45° field of view
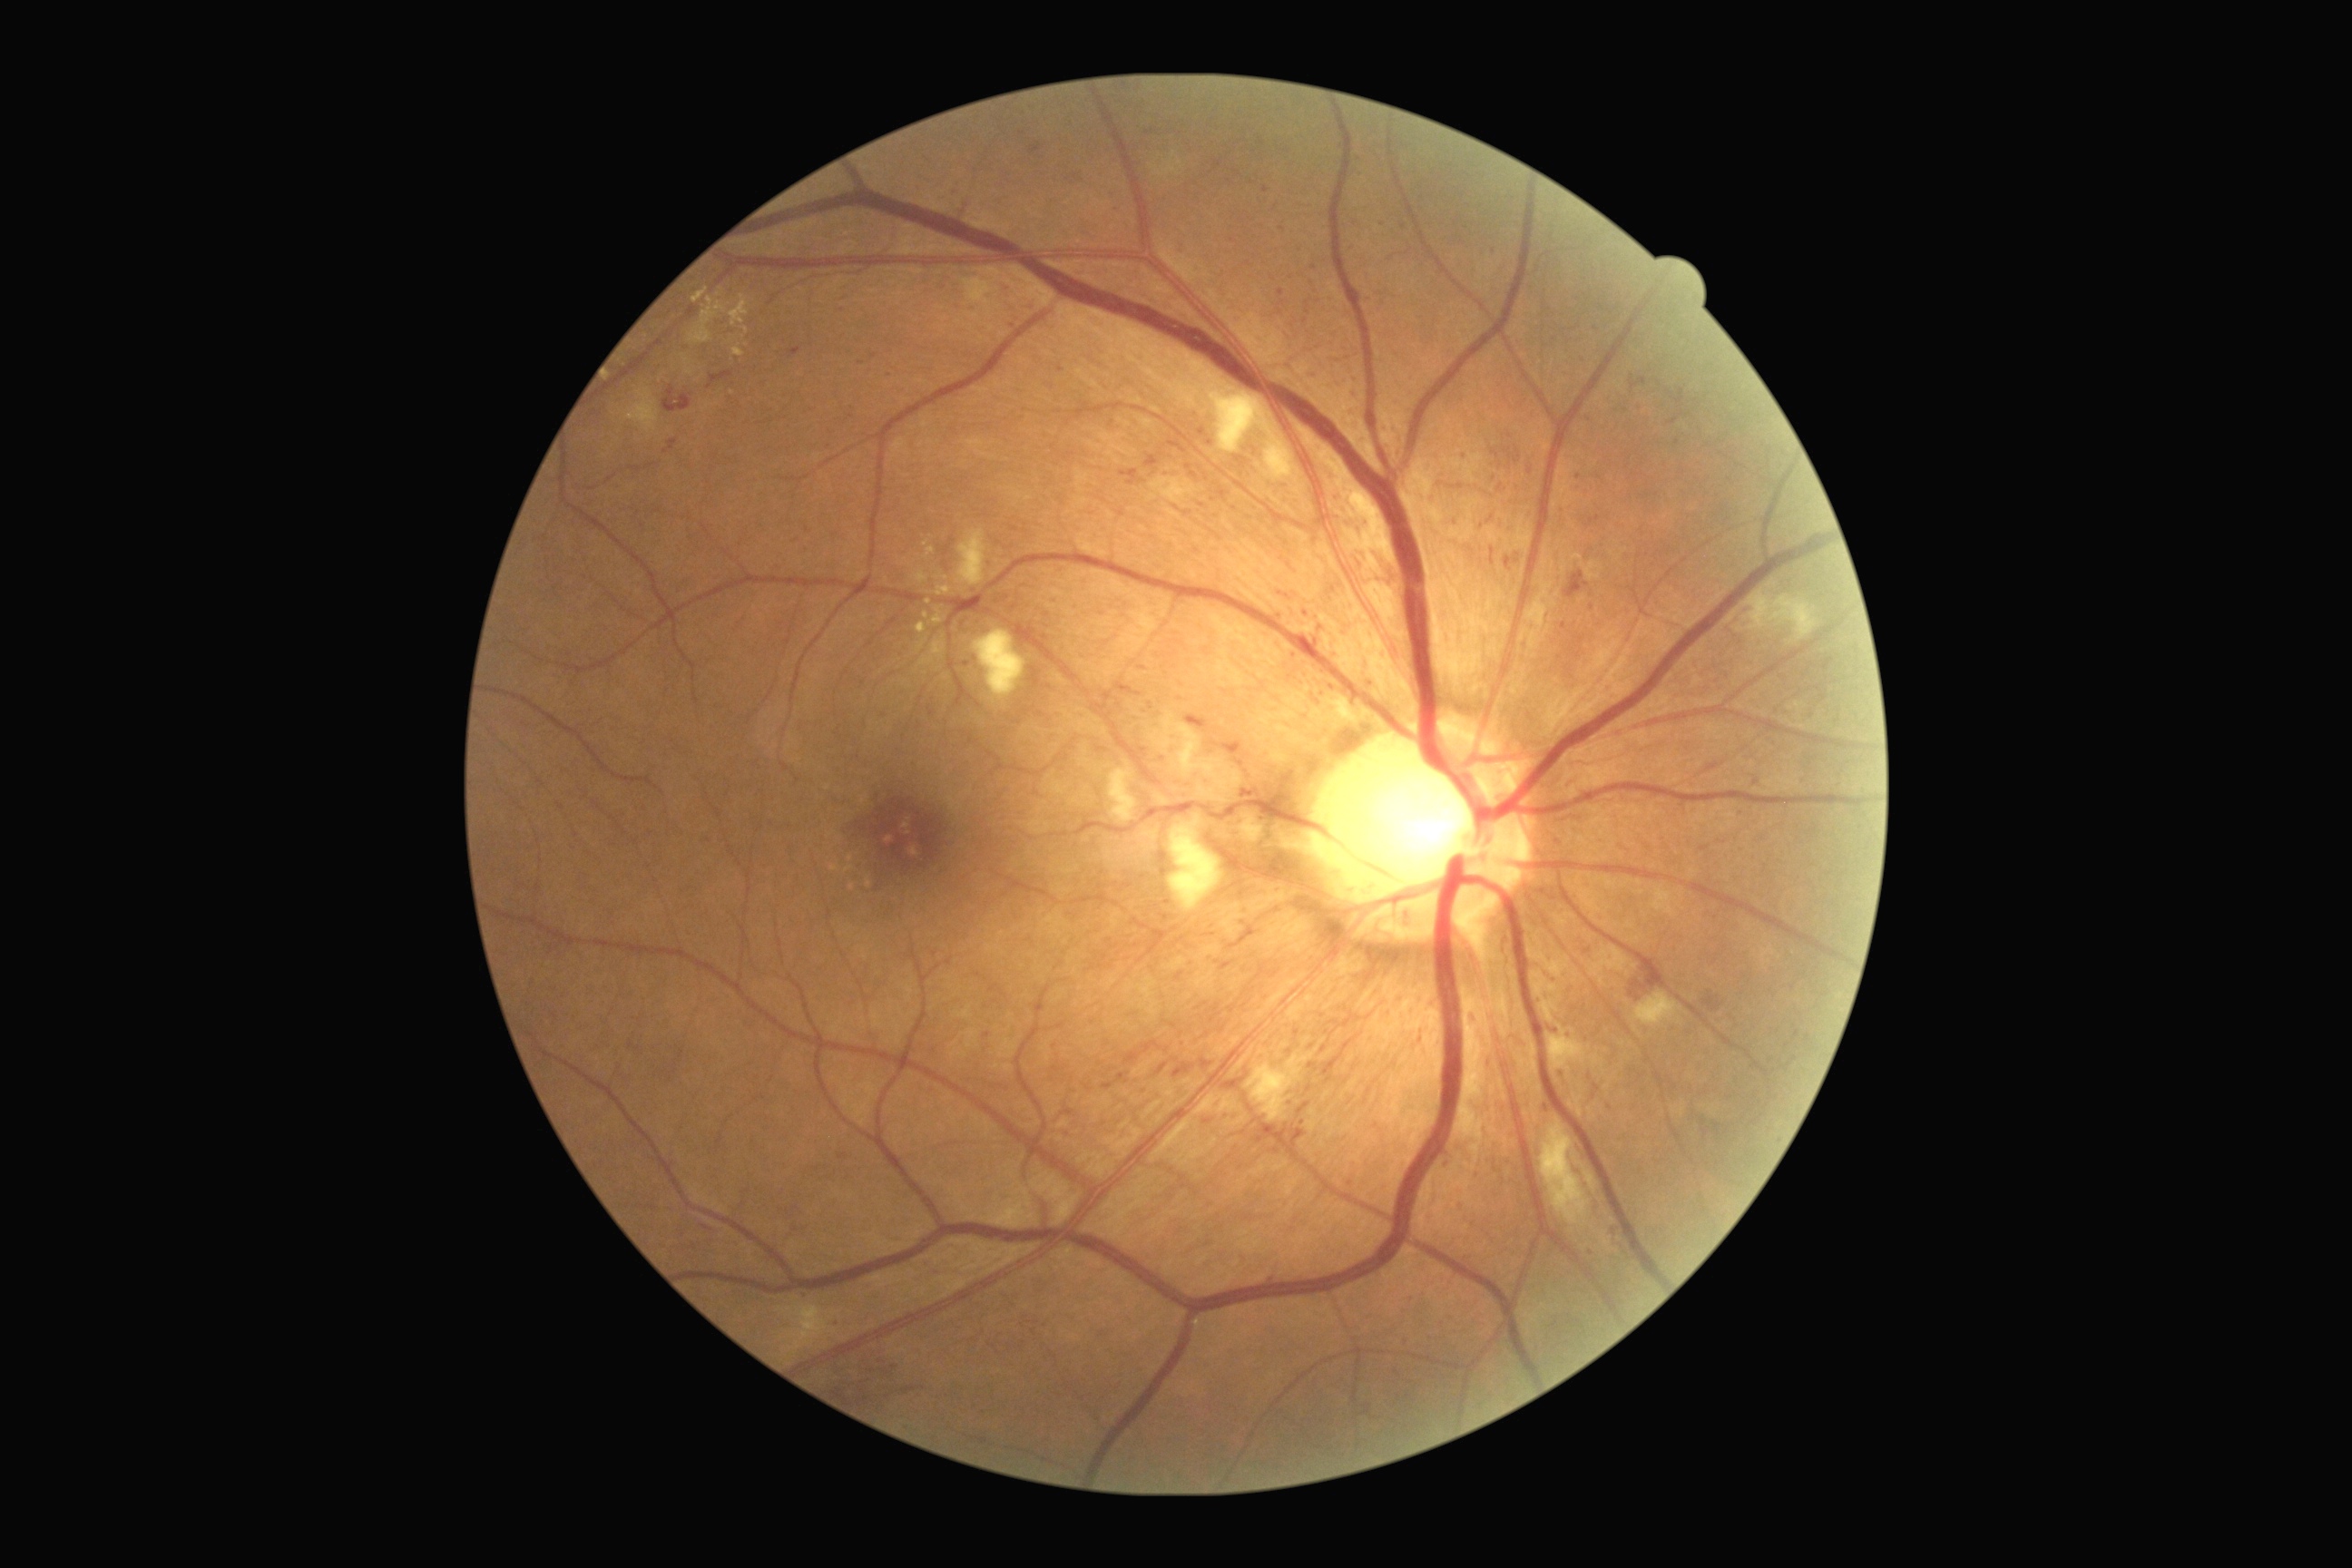 DR is grade 2 (moderate NPDR).